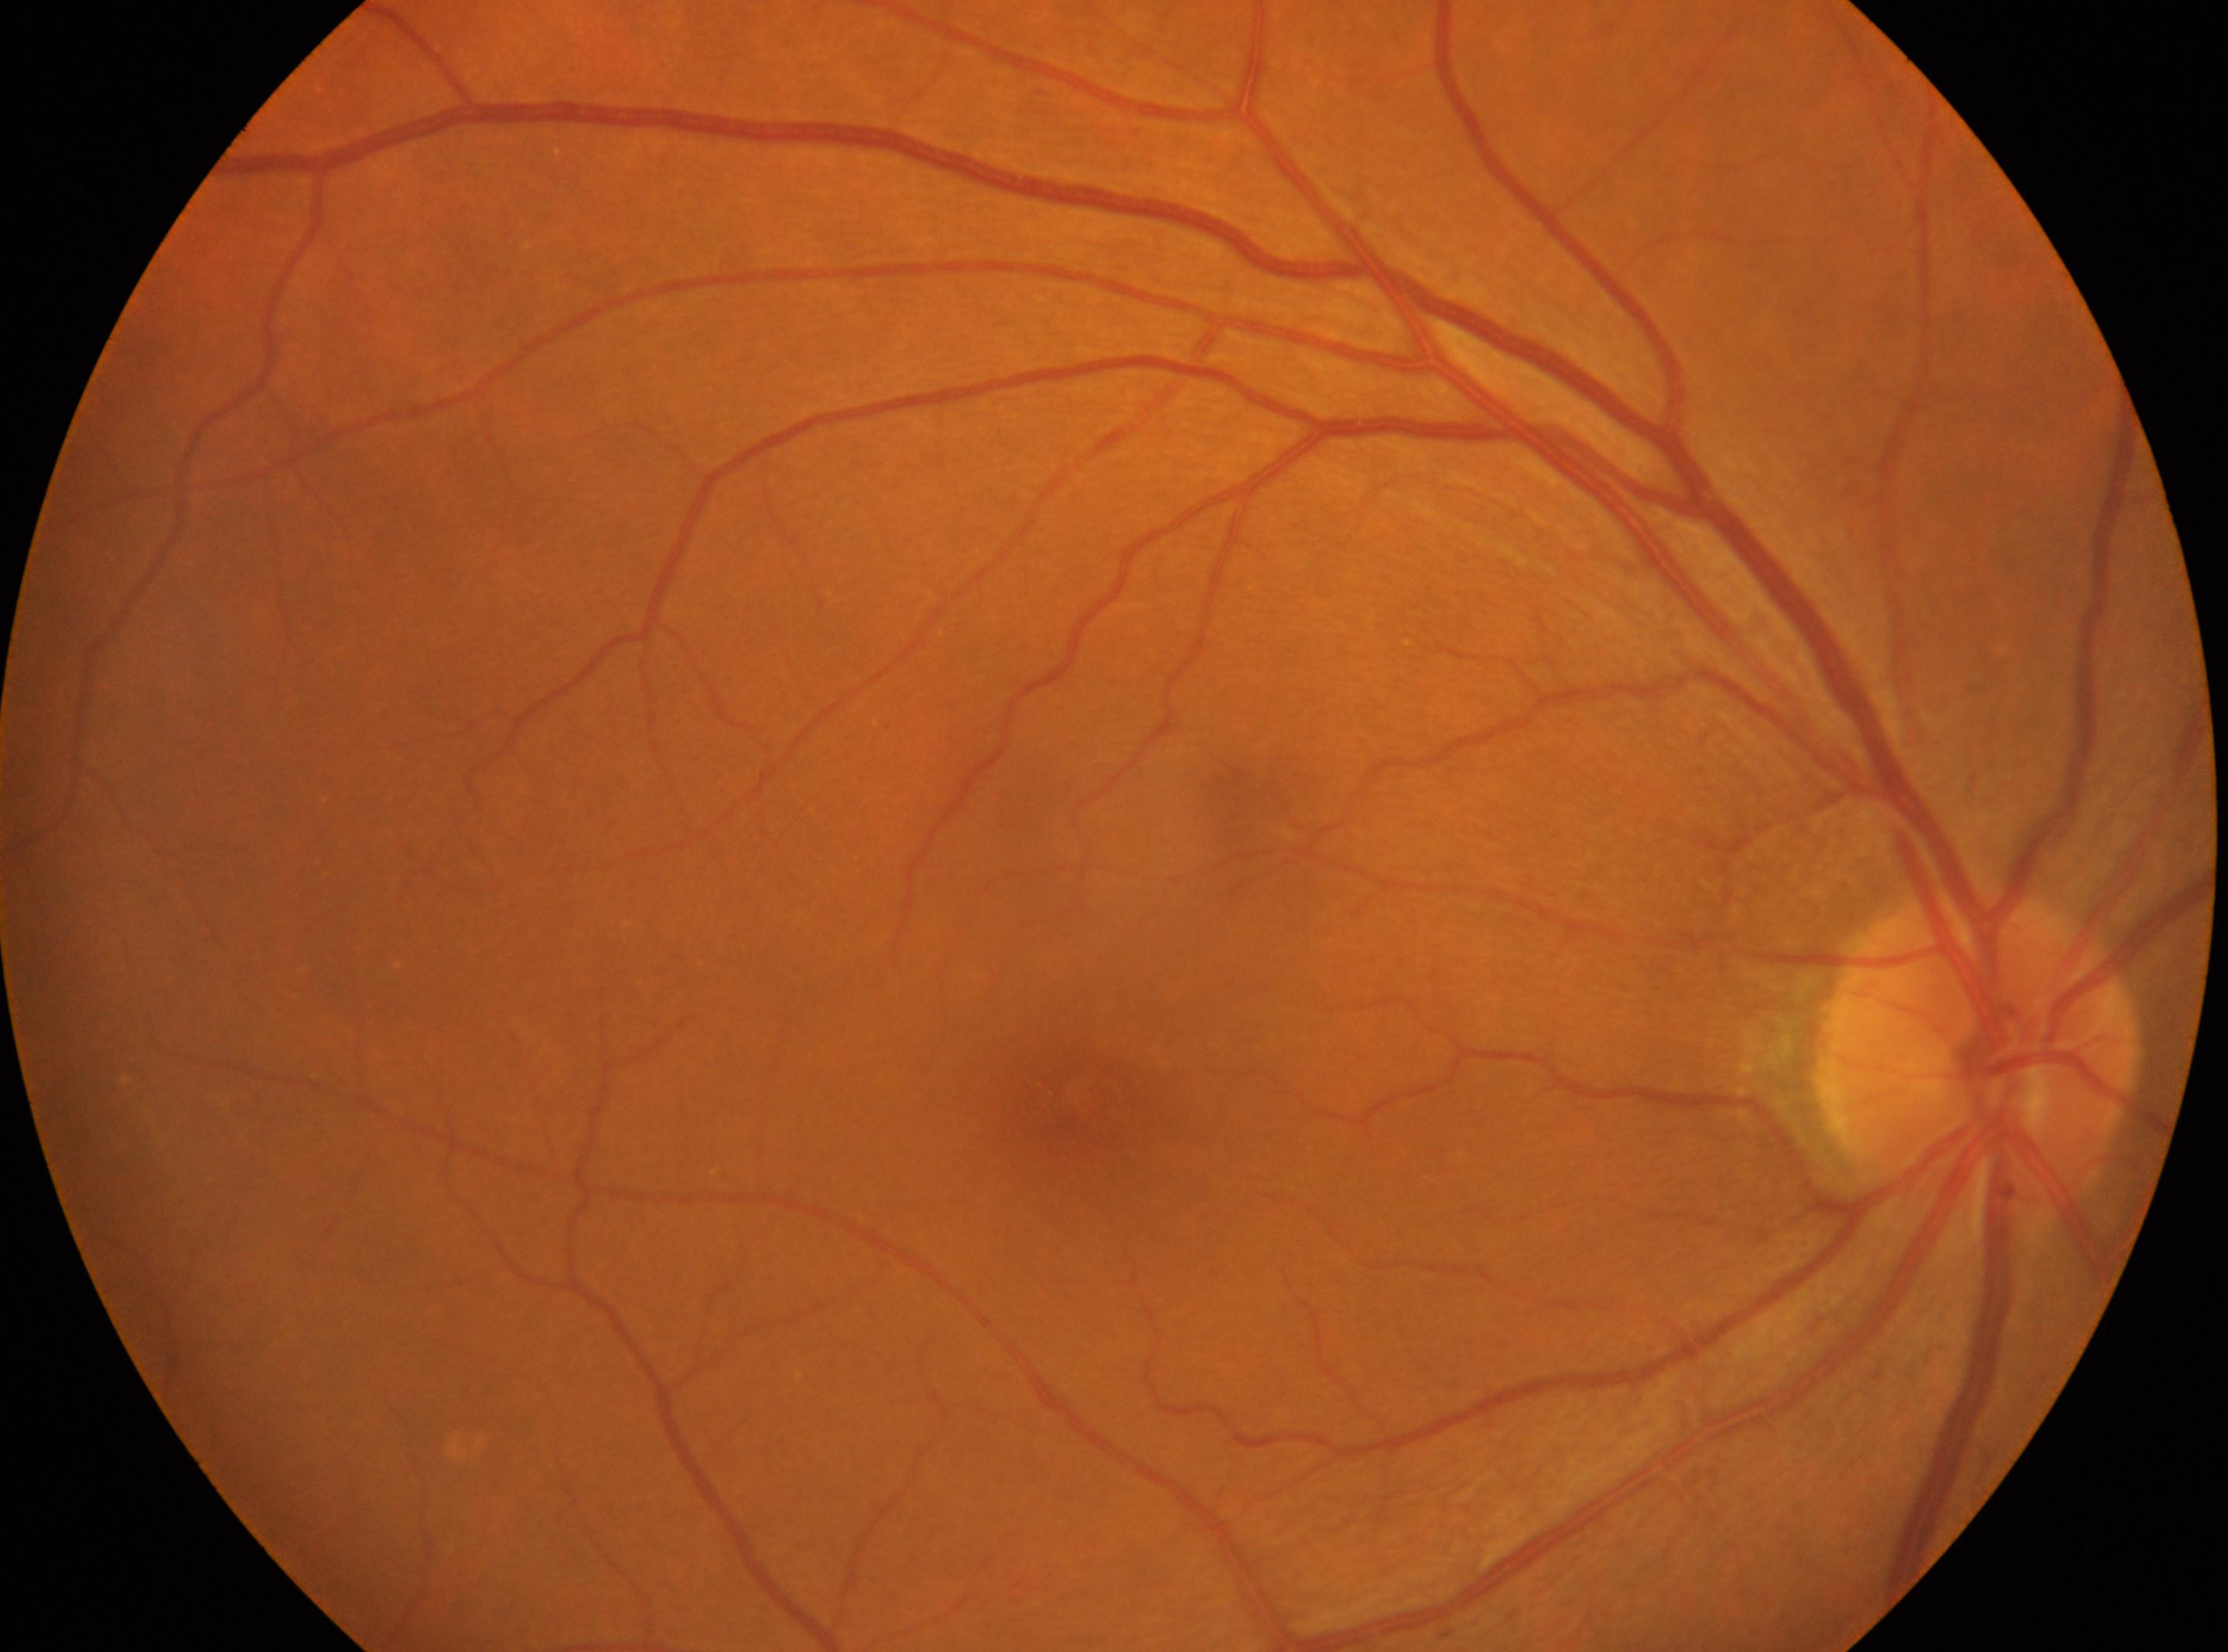 Eye: right. ONH located at x=1976, y=1052. The fovea centralis is at x=1069, y=1100. Diabetic retinopathy: no apparent diabetic retinopathy (grade 0) — no visible signs of diabetic retinopathy.